Wide-field contact fundus photograph of an infant.
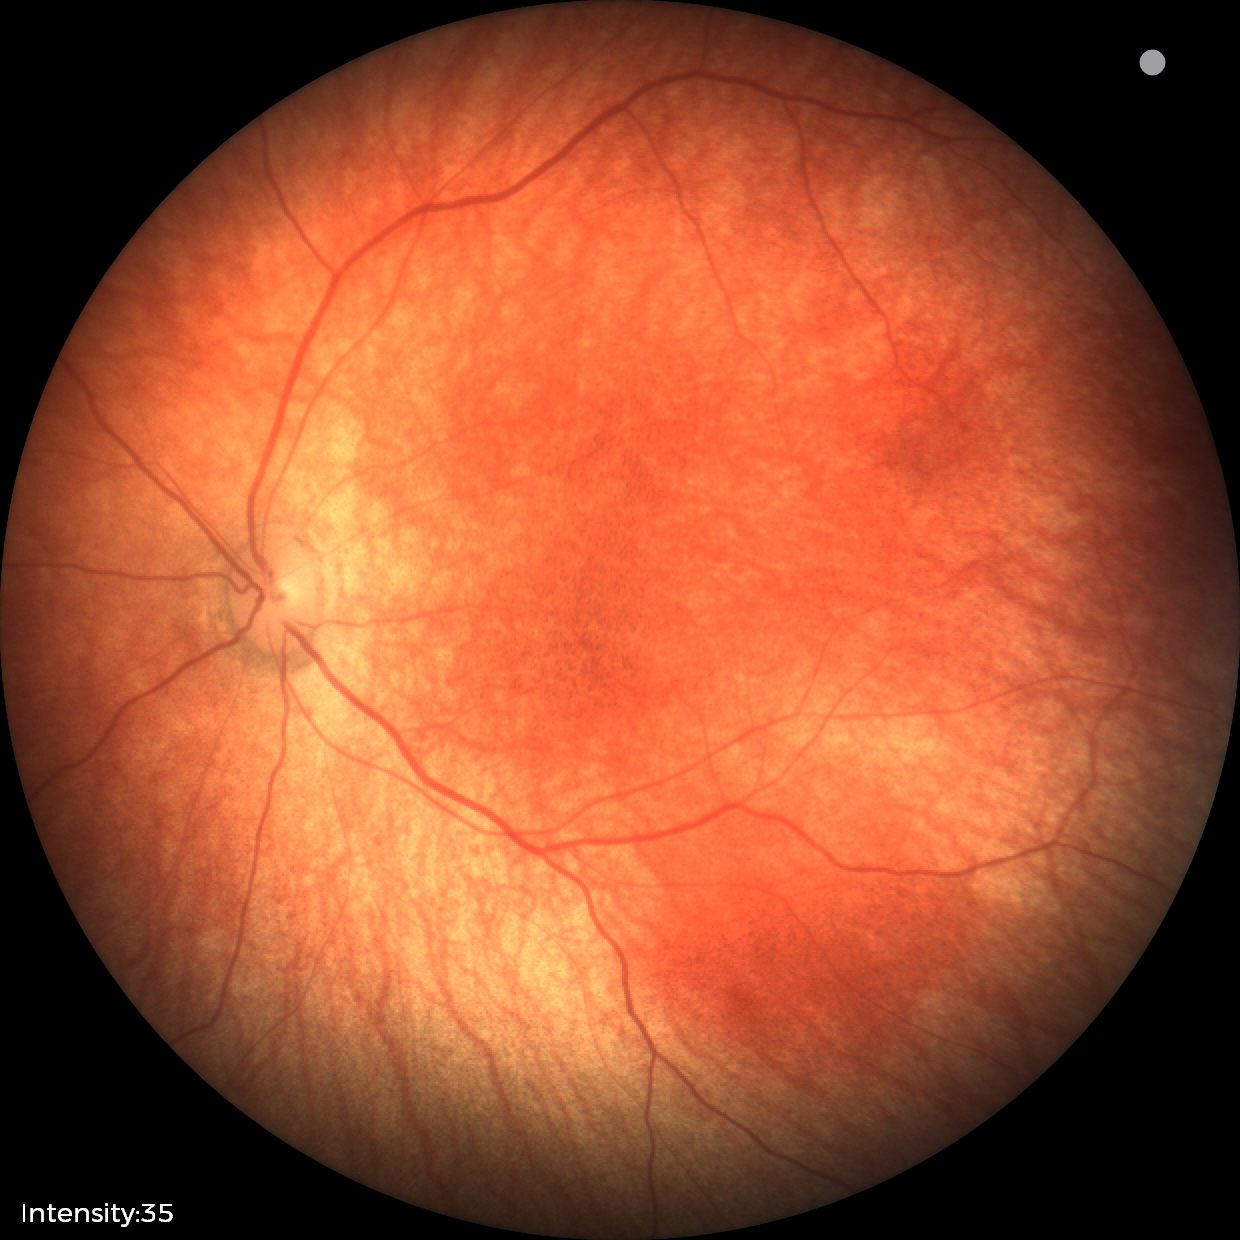 No retinal pathology identified on screening.